Intraocular pressure (IOP): 17 mmHg. Axial length 25.8 mm. Color fundus photograph — 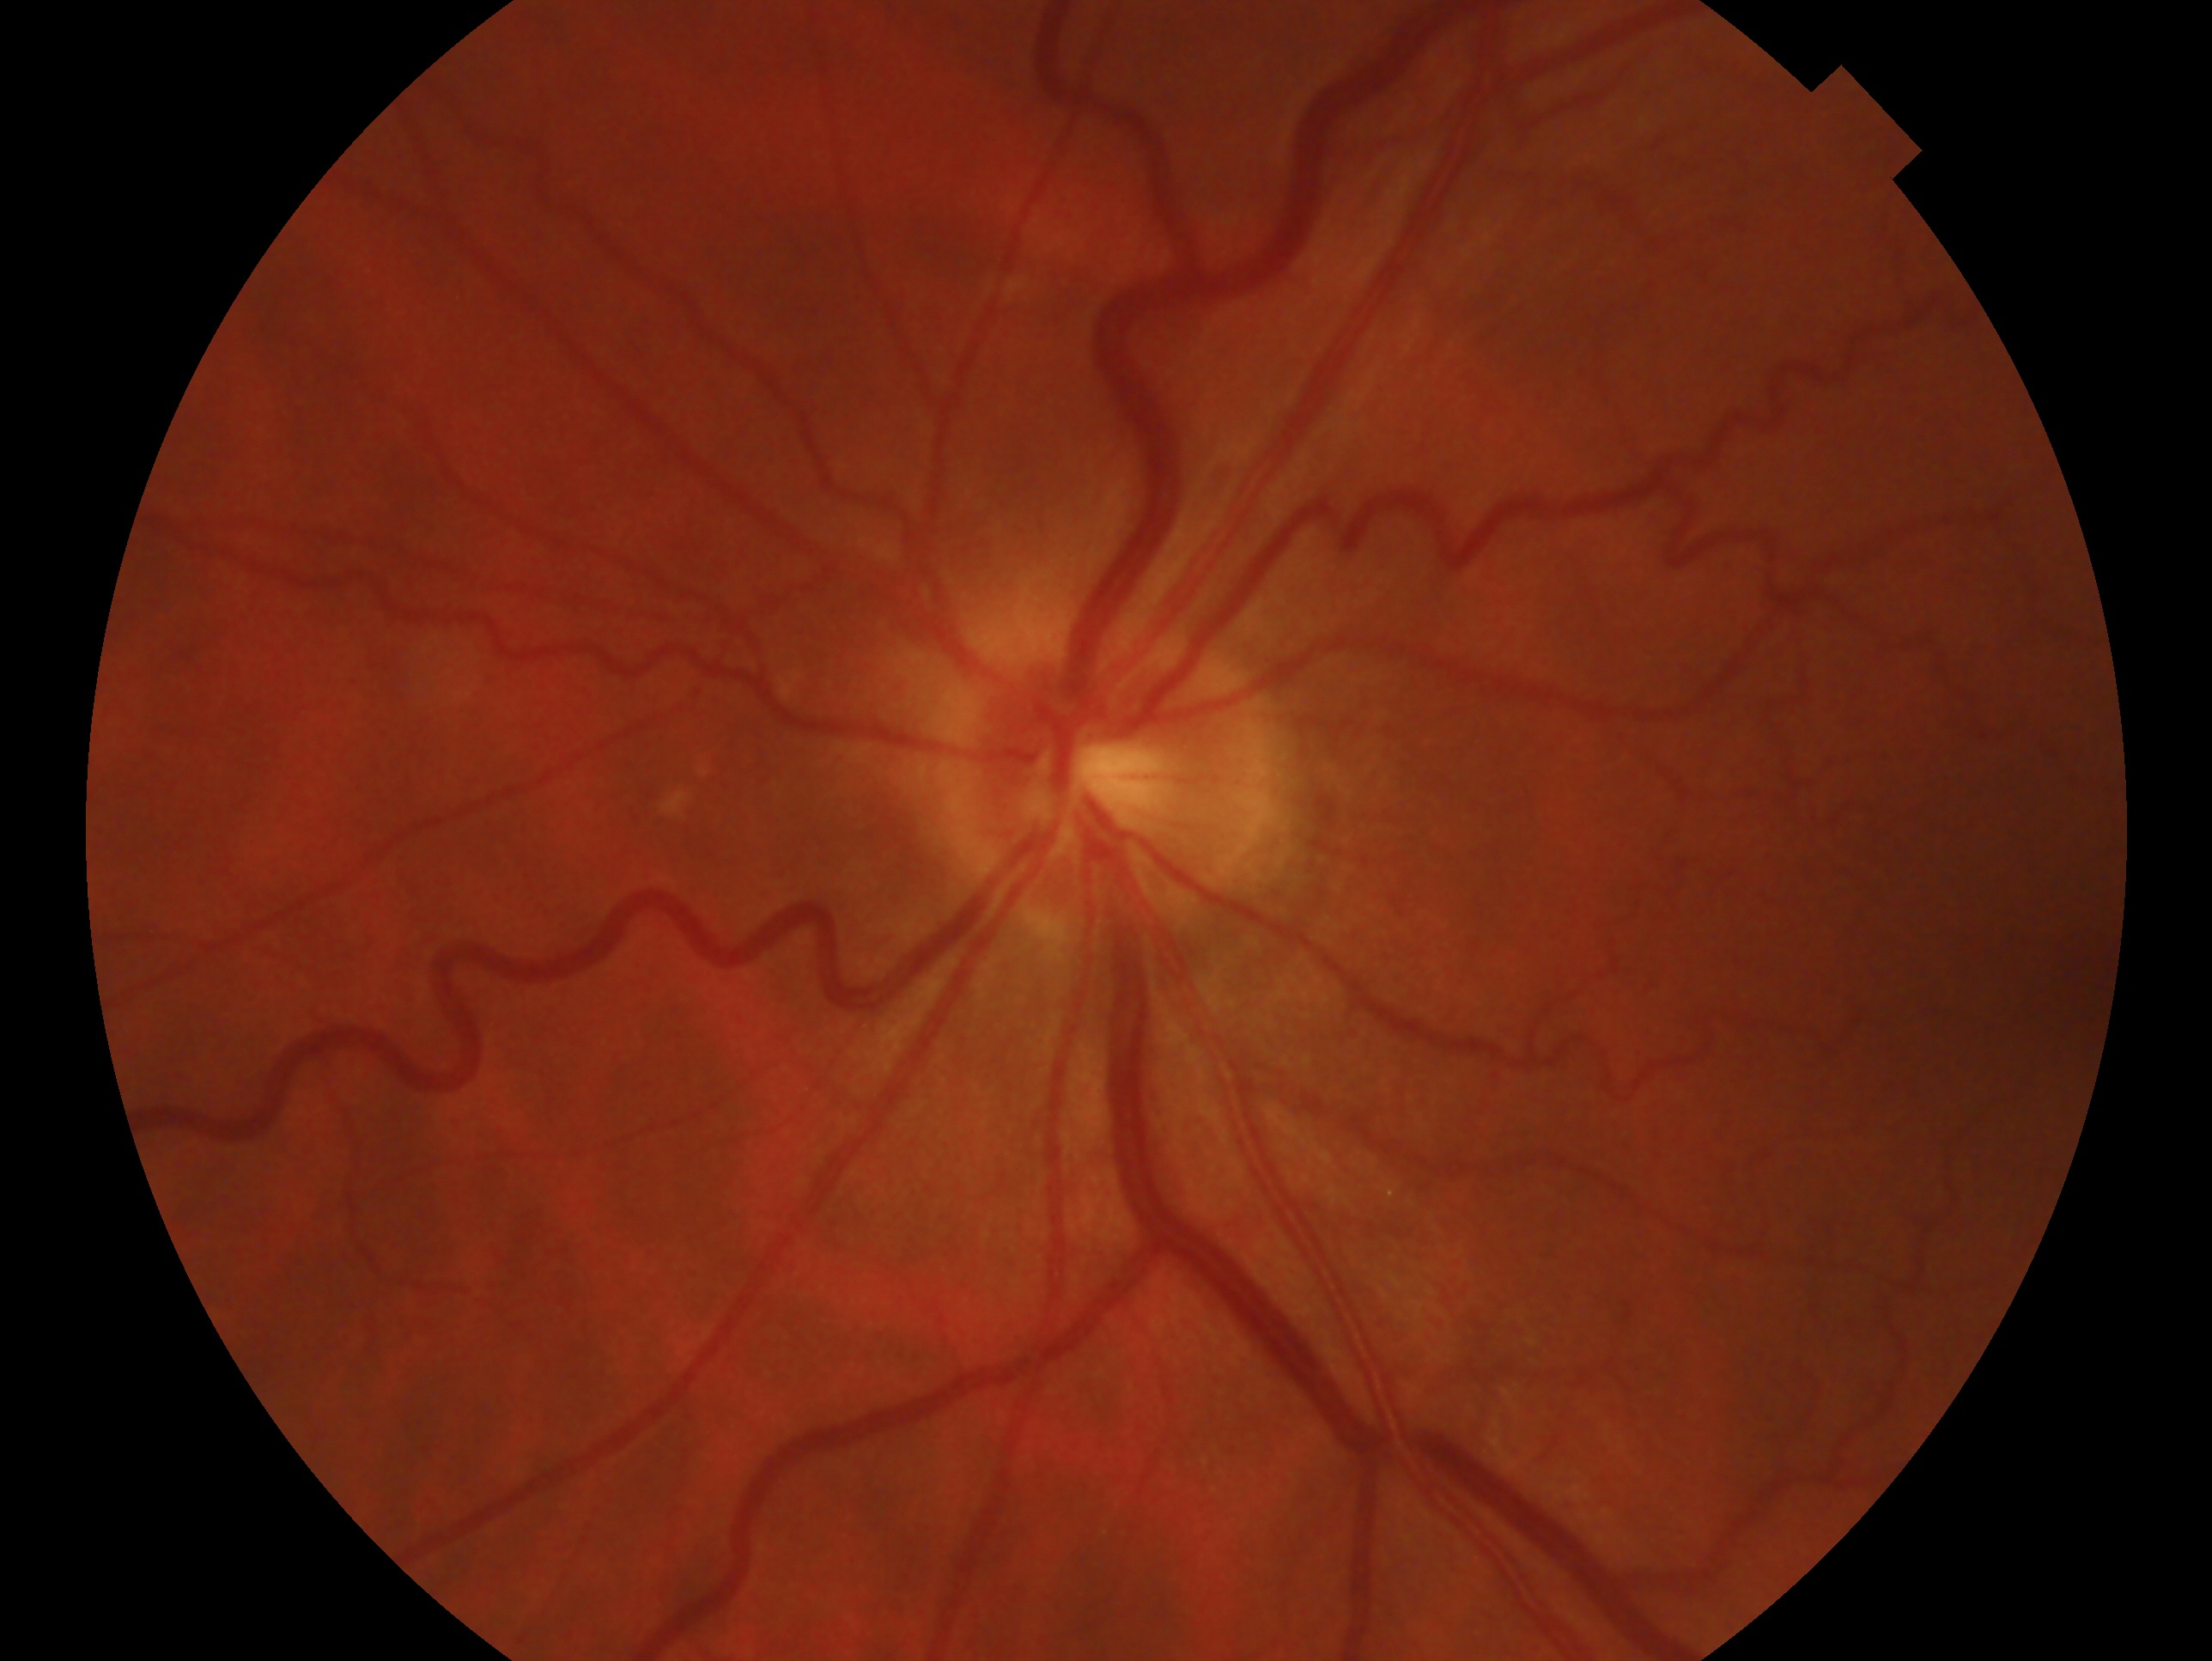

glaucoma diagnosis=no glaucoma; eye=OS.